1240x1240. Acquired on the Phoenix ICON. Wide-field fundus image from infant ROP screening: 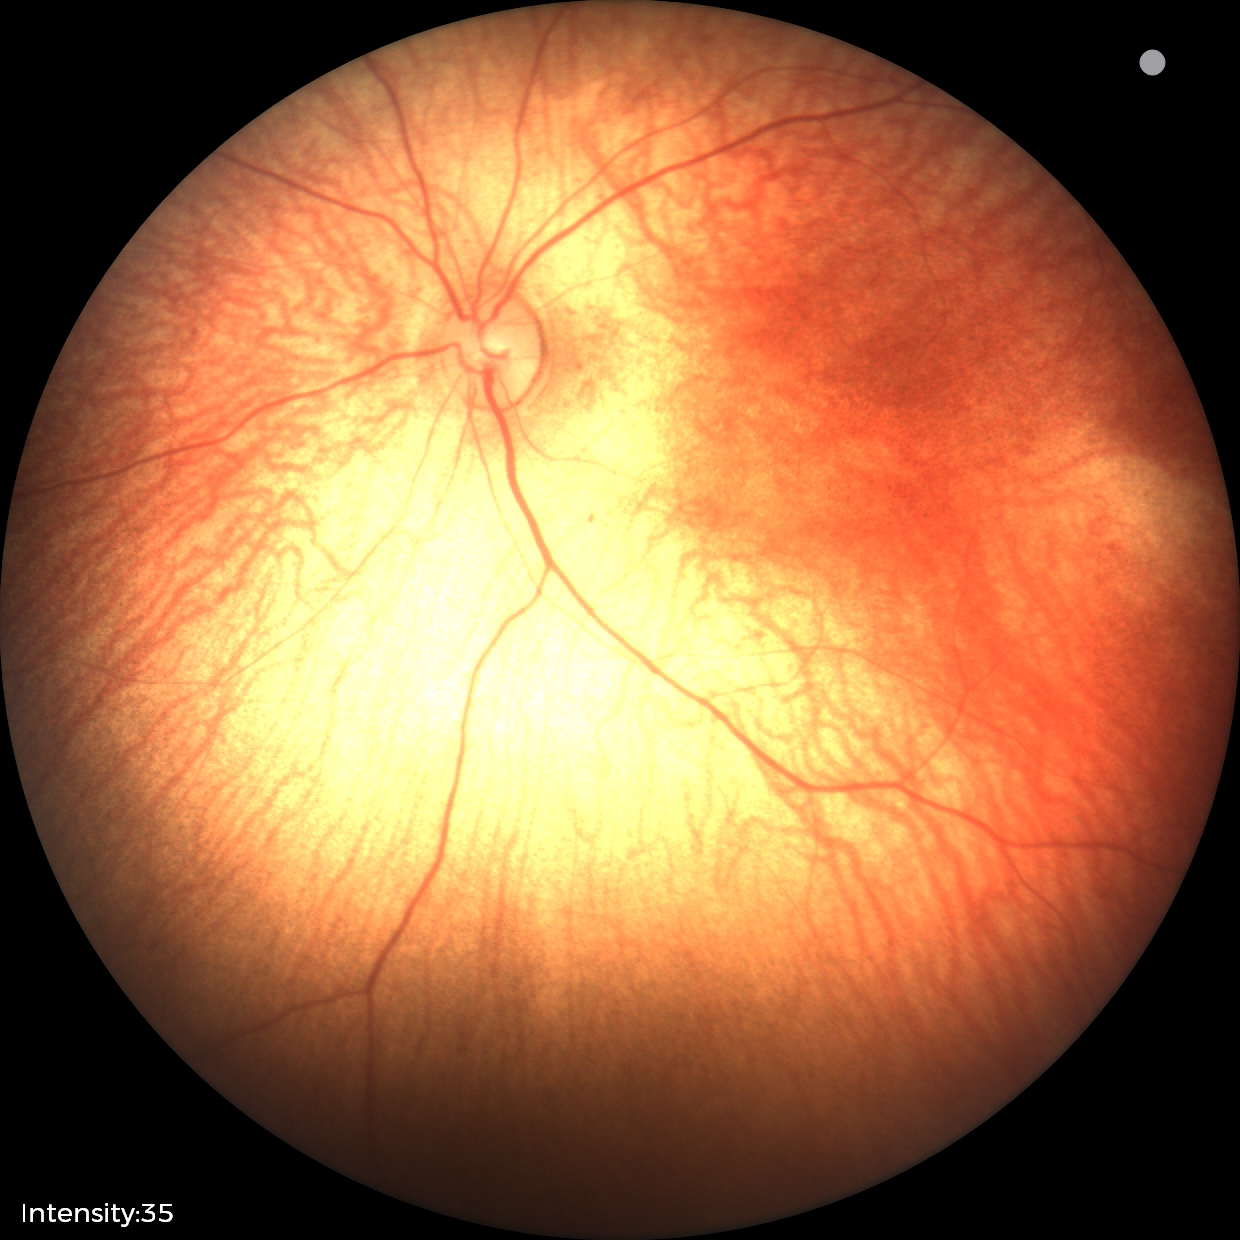 Screening: normal fundus examination.